Pediatric wide-field fundus photograph. 1240x1240 — 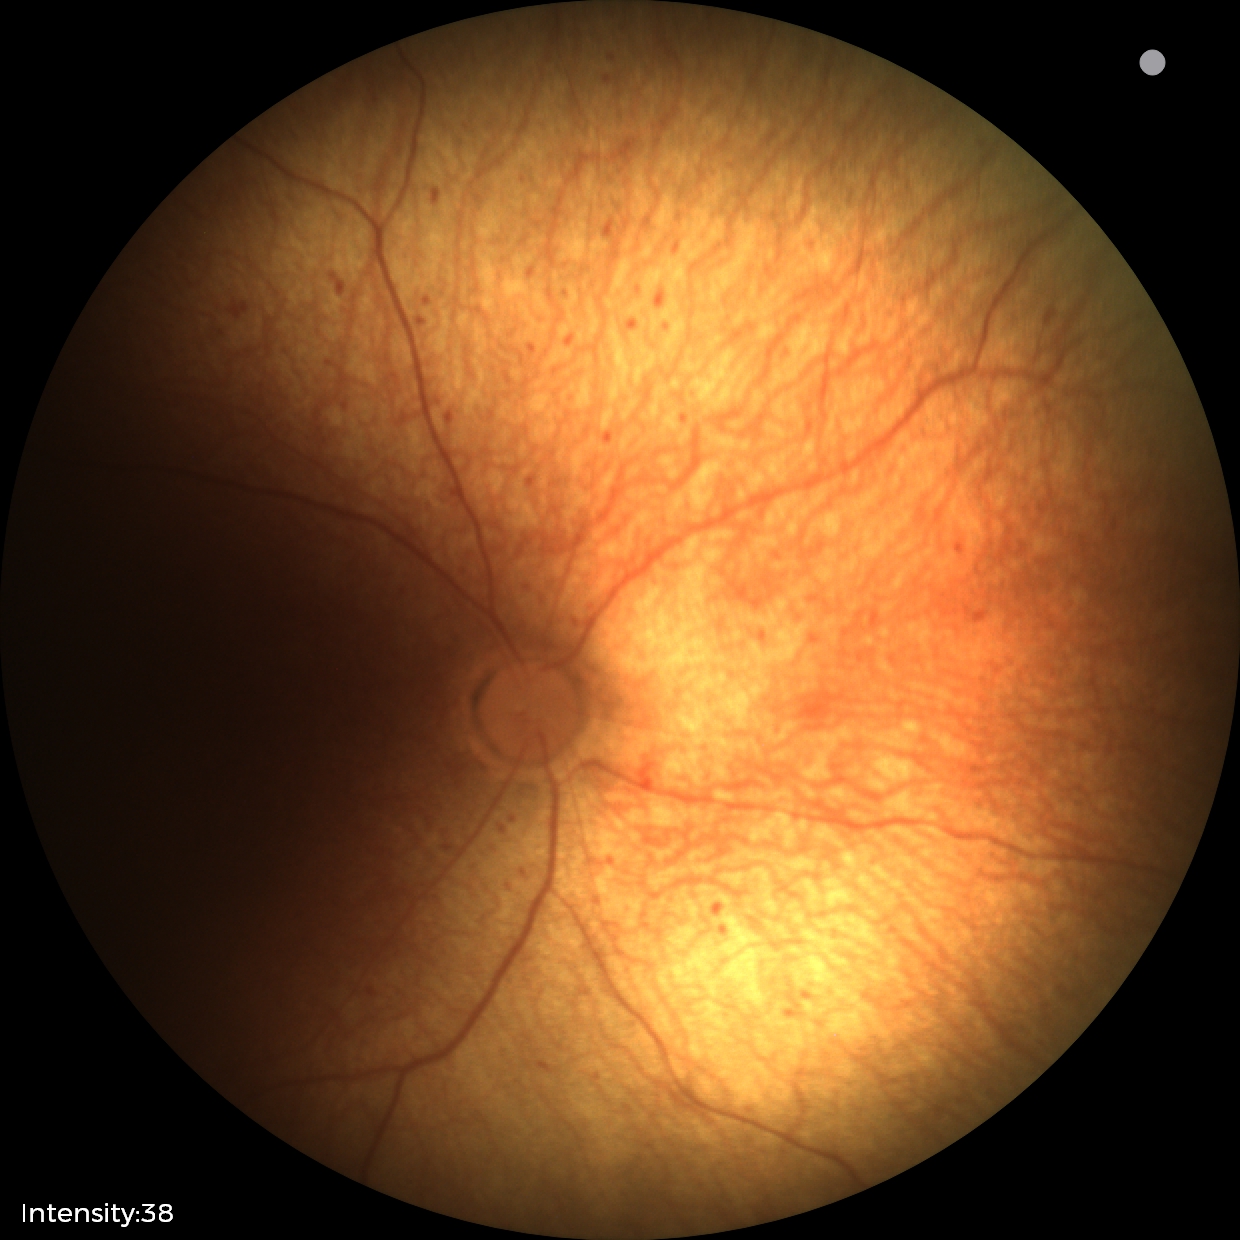

Finding: status post ROP — retinal appearance after treated retinopathy of prematurity | plus form: absent.